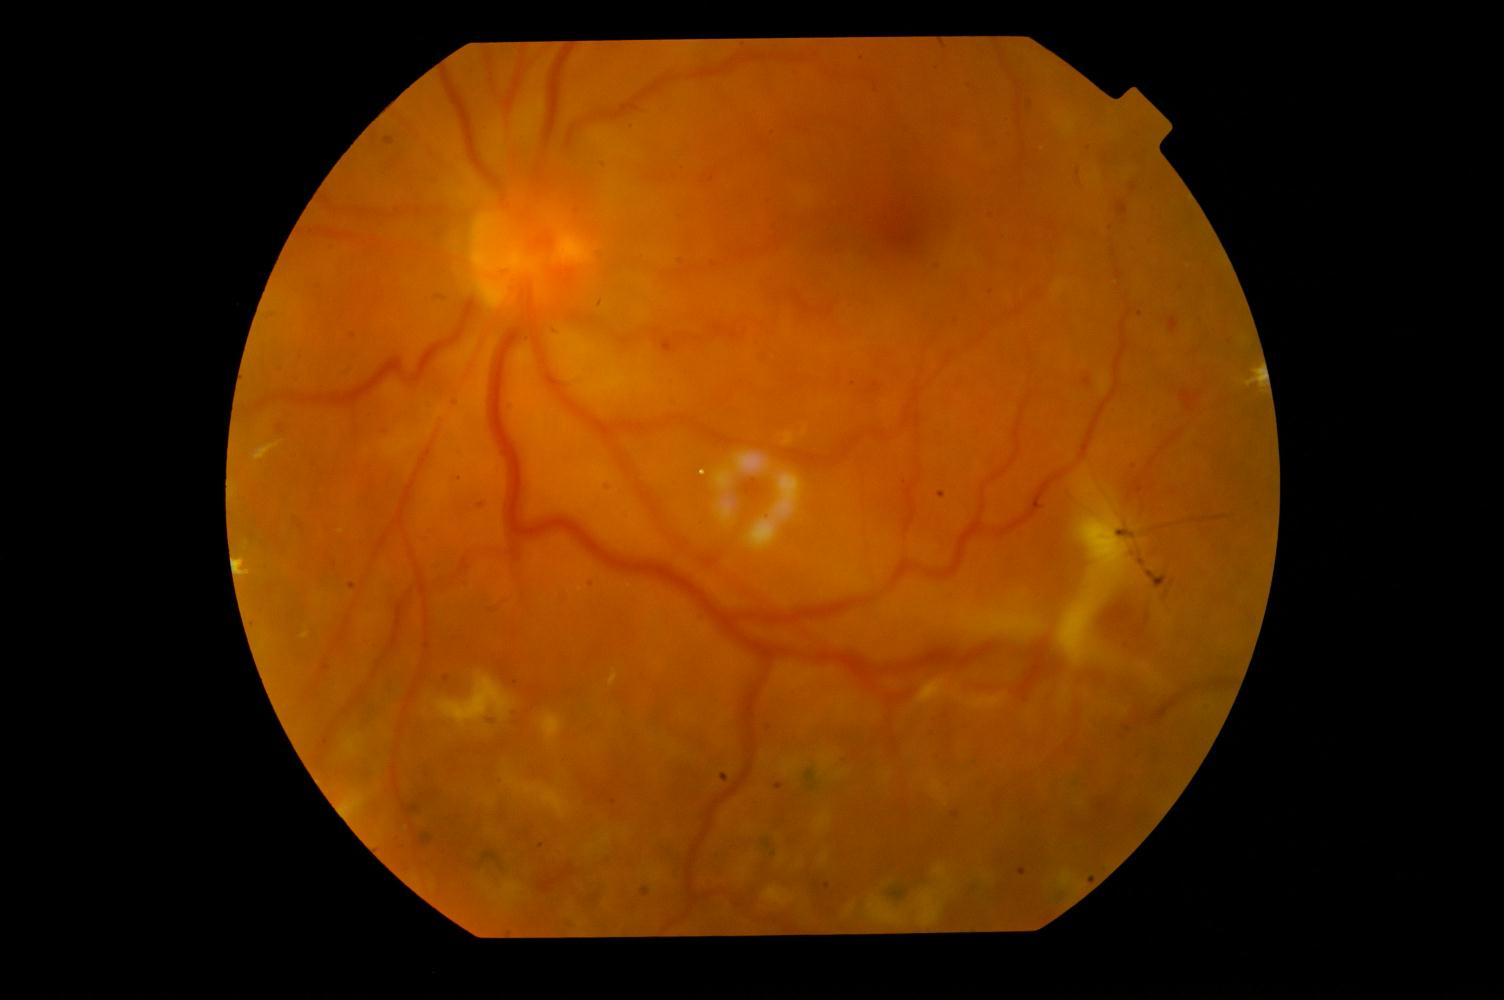
Pathology: diabetic retinopathy.